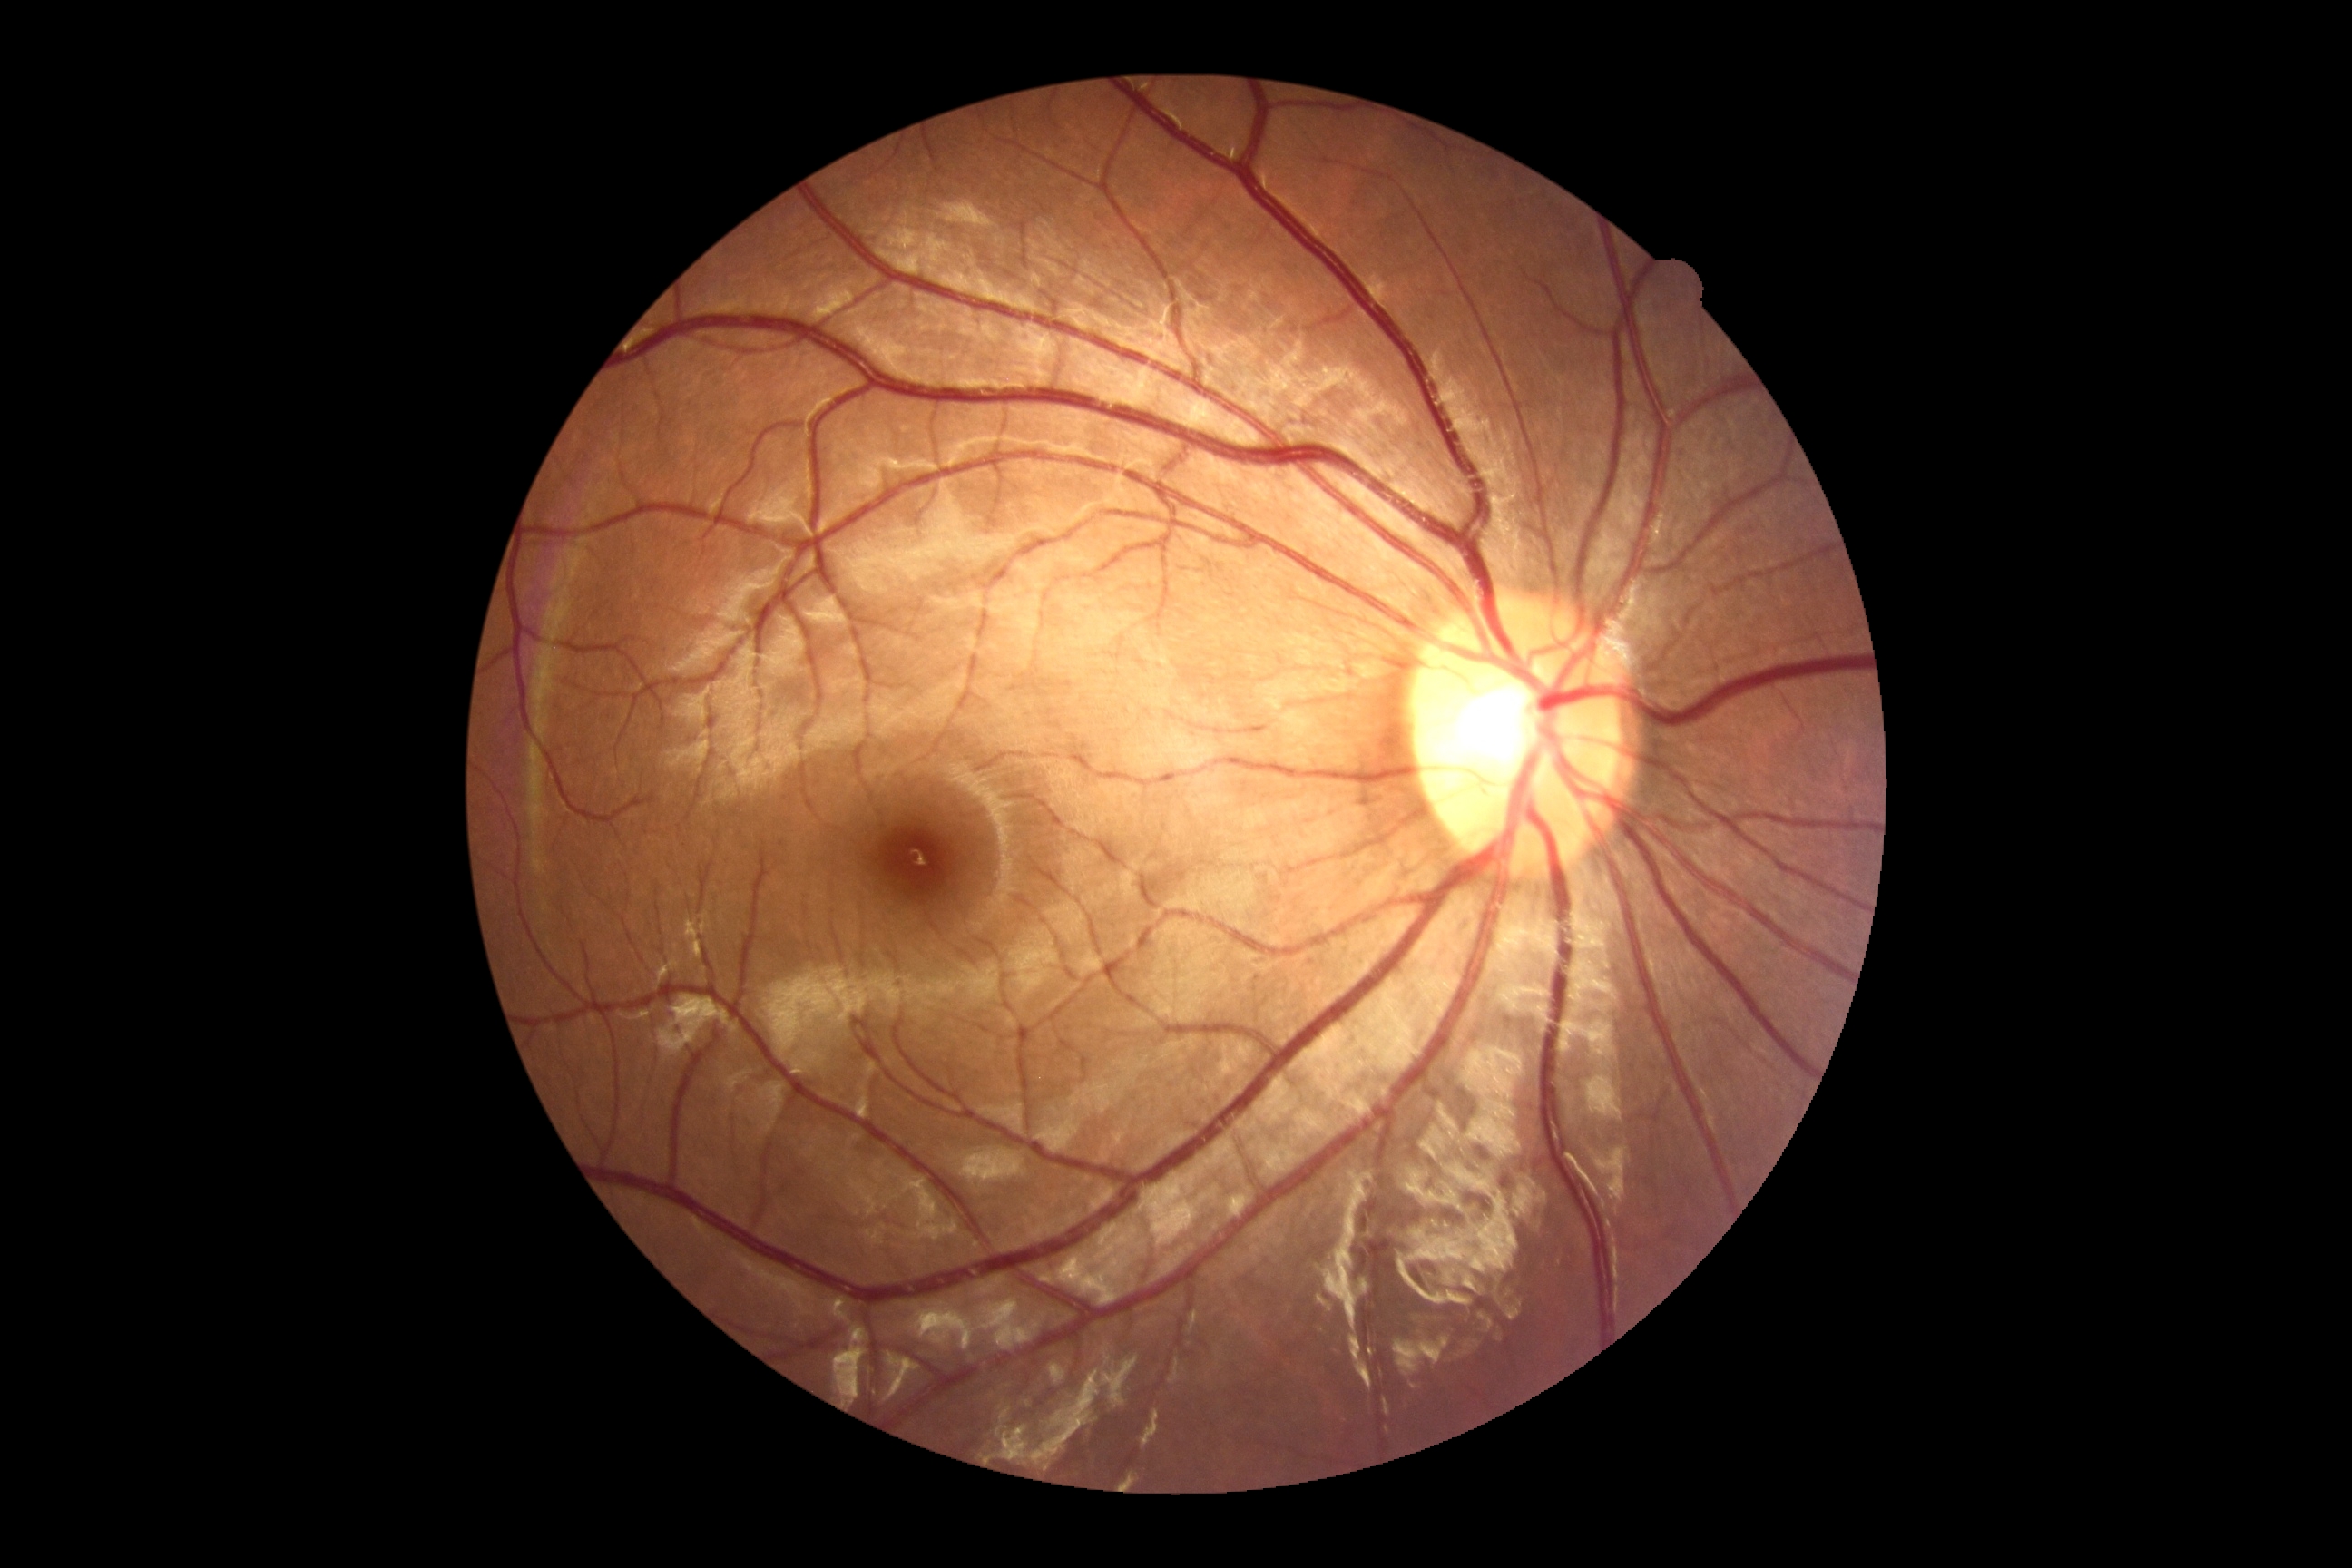
Findings:
- DR severity — no apparent retinopathy (grade 0)